Graded on the modified Davis scale. Without pupil dilation:
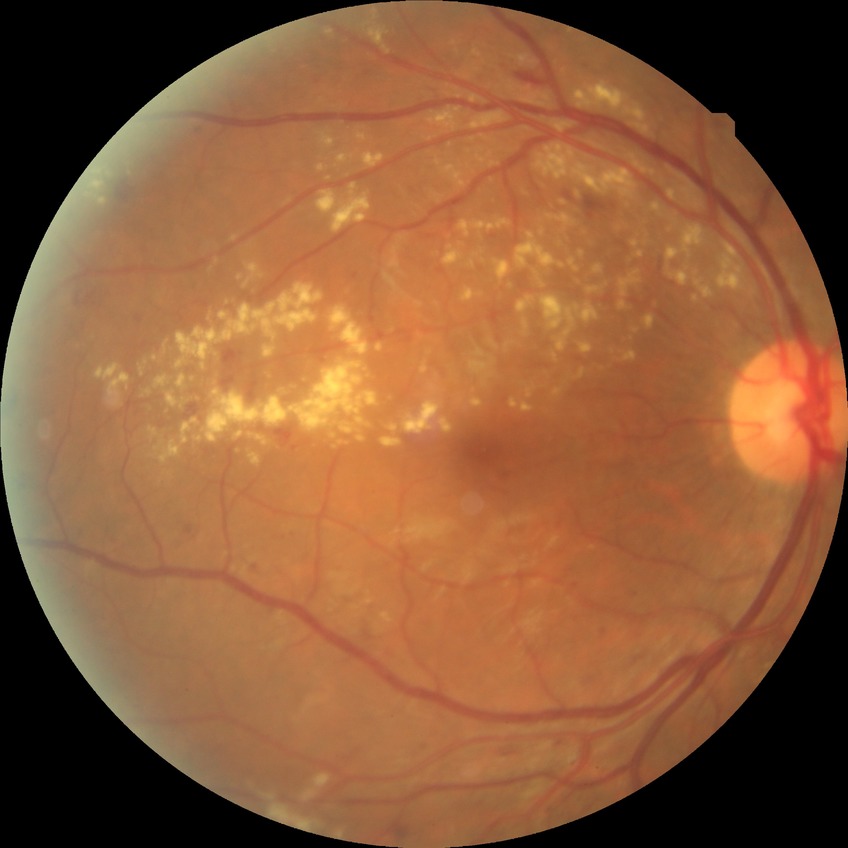 Retinopathy grade: pre-proliferative diabetic retinopathy.